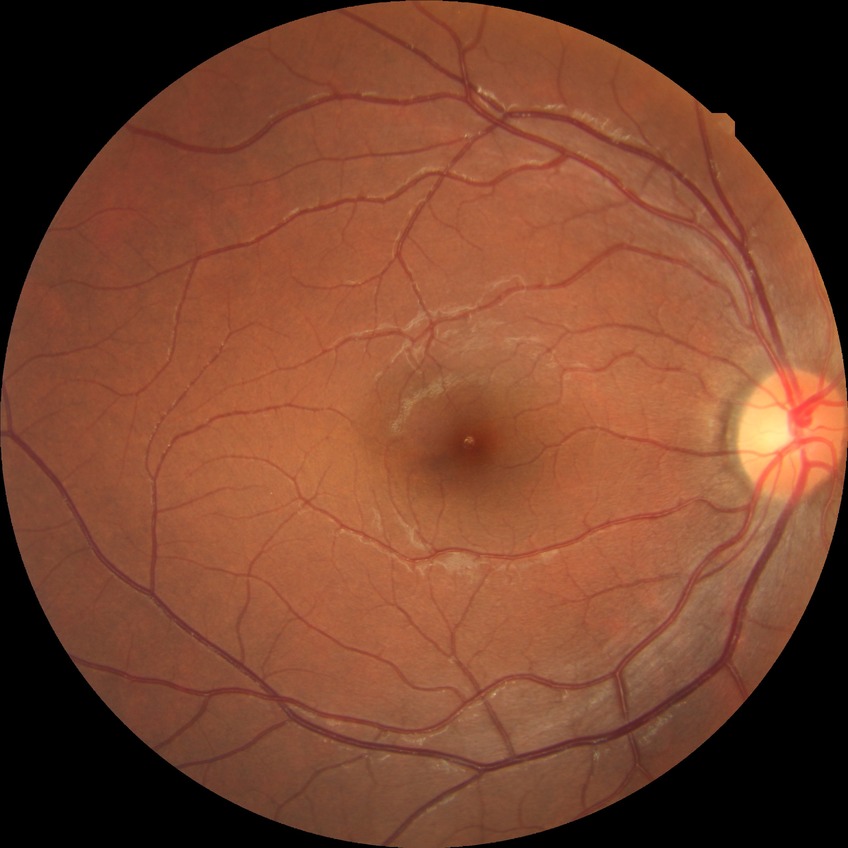

Diabetic retinopathy (DR) is NDR (no diabetic retinopathy).